Modified Davis classification, 45-degree field of view, nonmydriatic, NIDEK AFC-230 fundus camera:
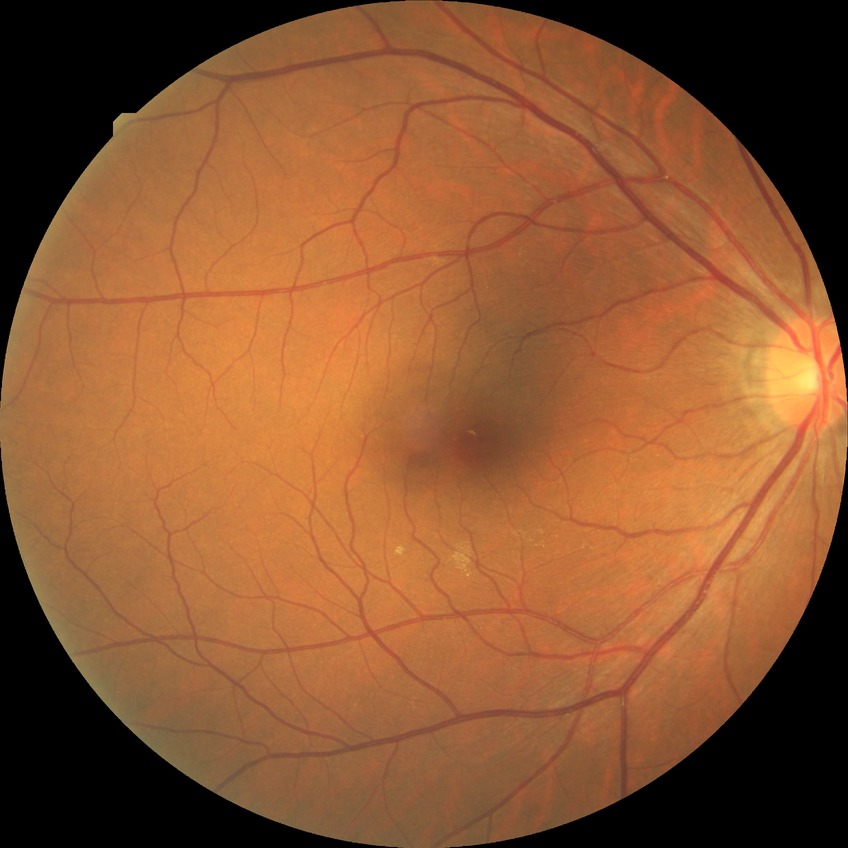
Diabetic retinopathy (DR): NDR (no diabetic retinopathy).